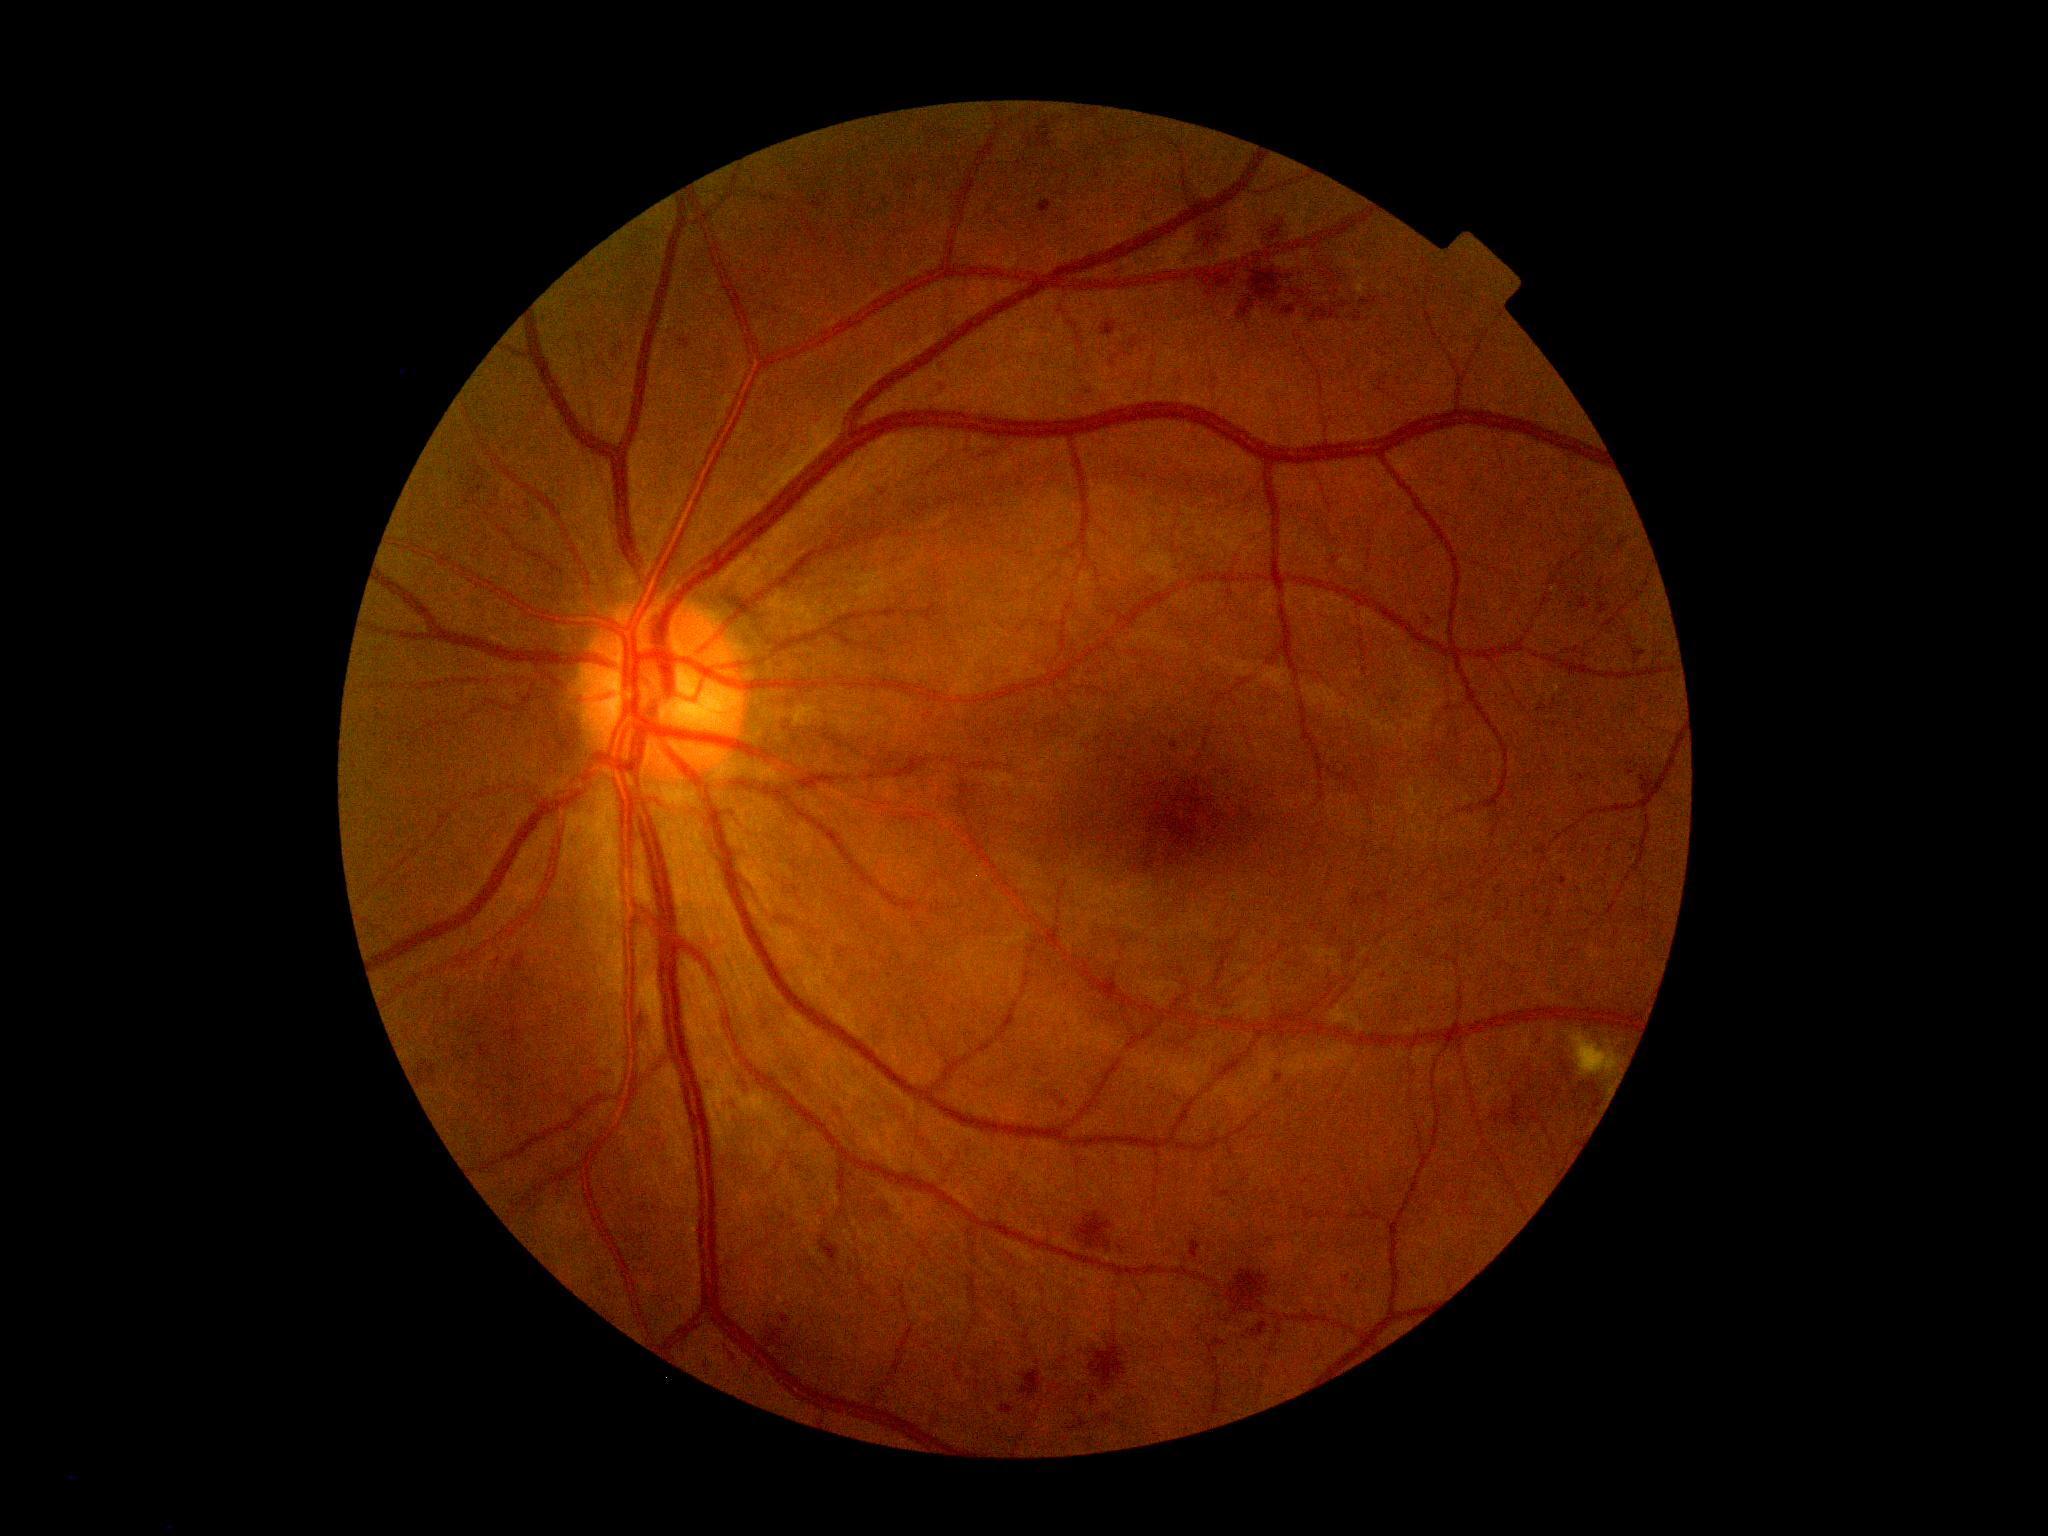

{"dr_grade": "moderate NPDR (grade 2)", "dr_category": "non-proliferative diabetic retinopathy"}